Posterior pole color fundus photograph. 848 x 848 pixels: 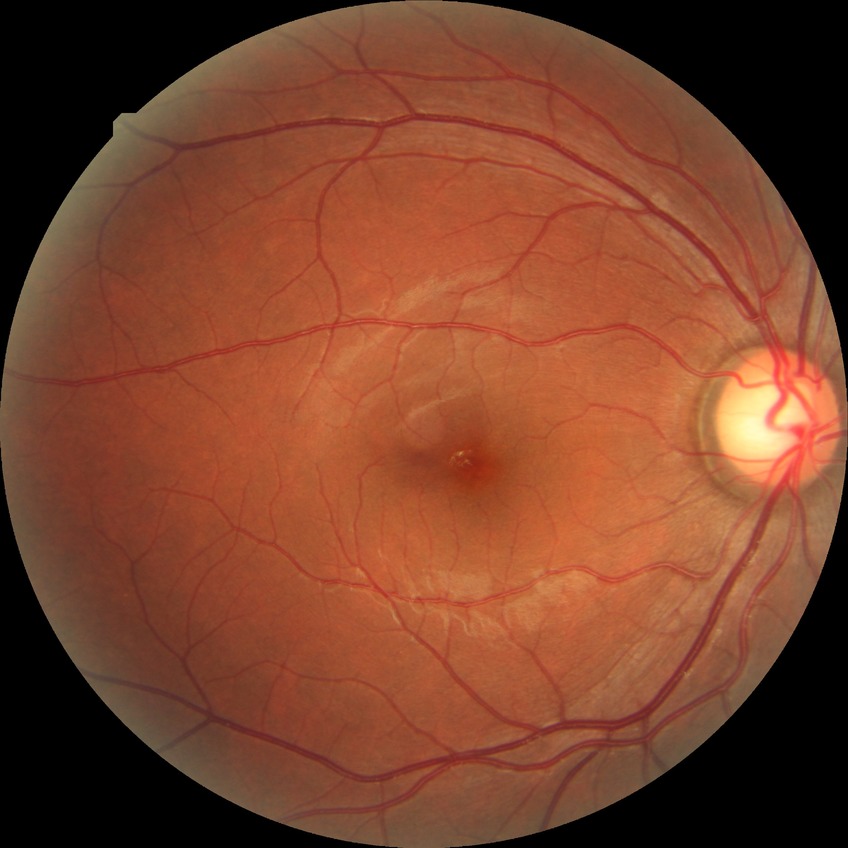 Diabetic retinopathy (DR) is NDR (no diabetic retinopathy).